45-degree field of view:
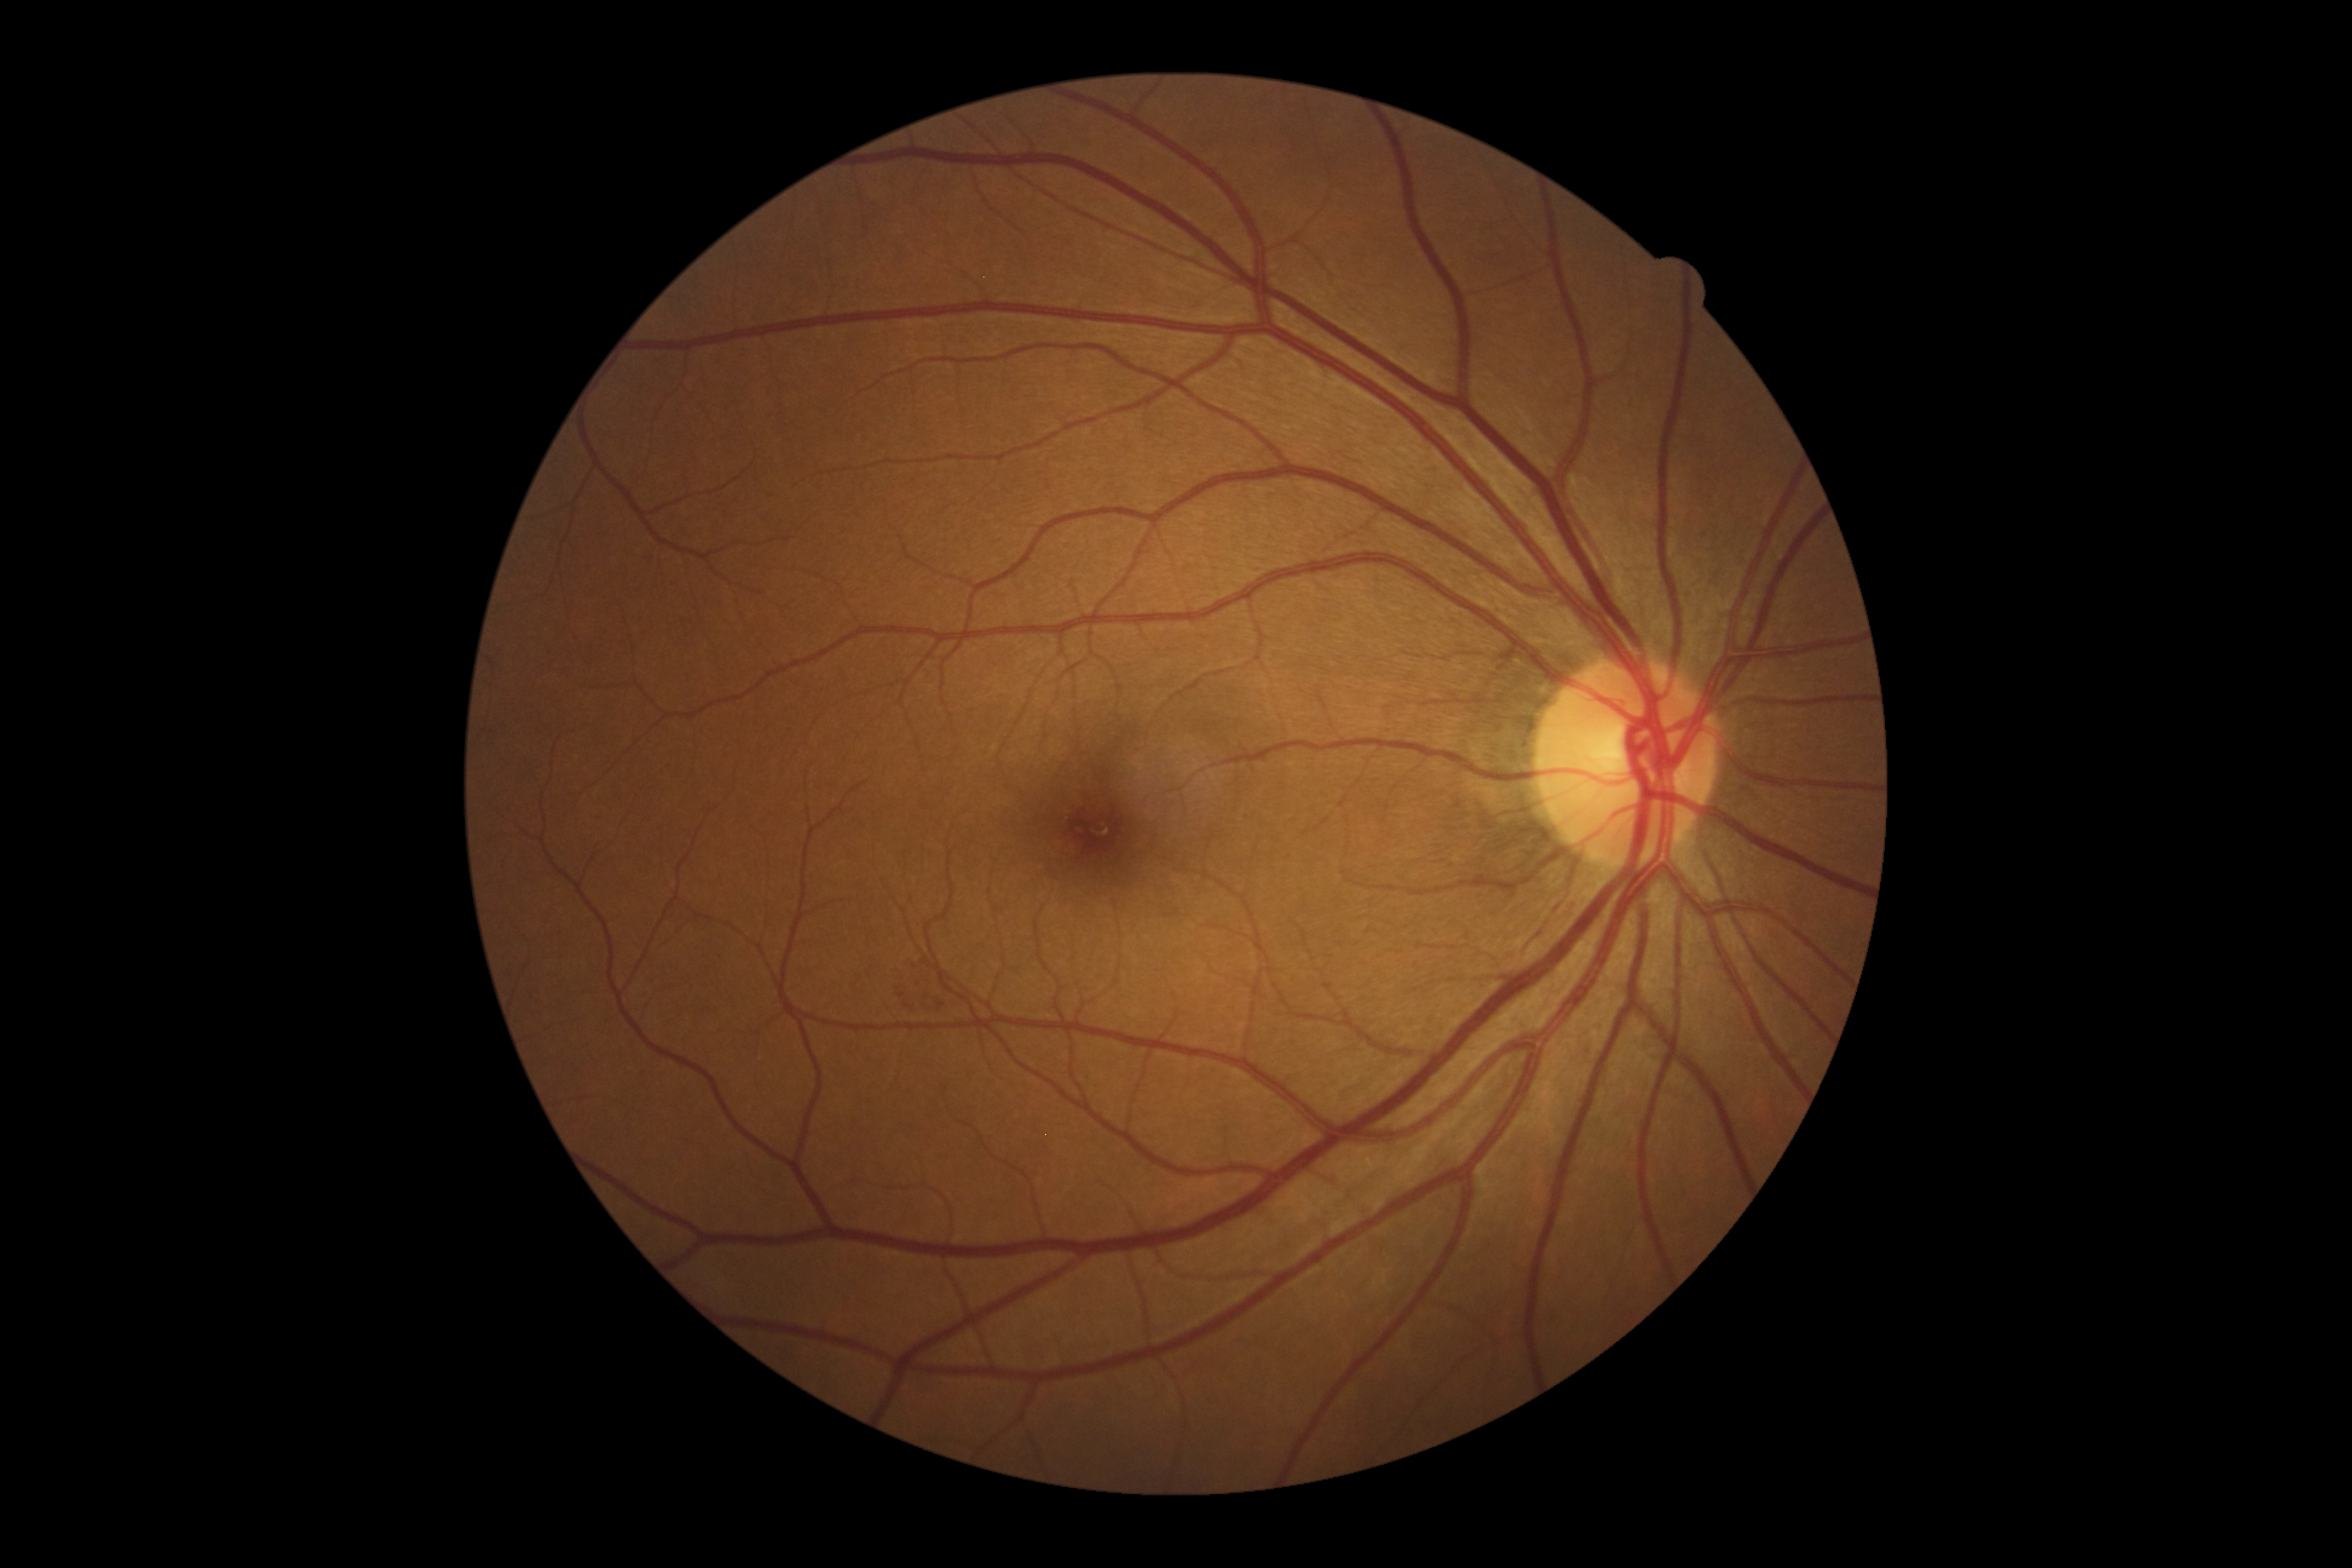
diabetic retinopathy = grade 2 (moderate NPDR) — more than just microaneurysms but less than severe NPDR